Color fundus photograph, 848 by 848 pixels, modified Davis classification, NIDEK AFC-230, without pupil dilation, 45° field of view
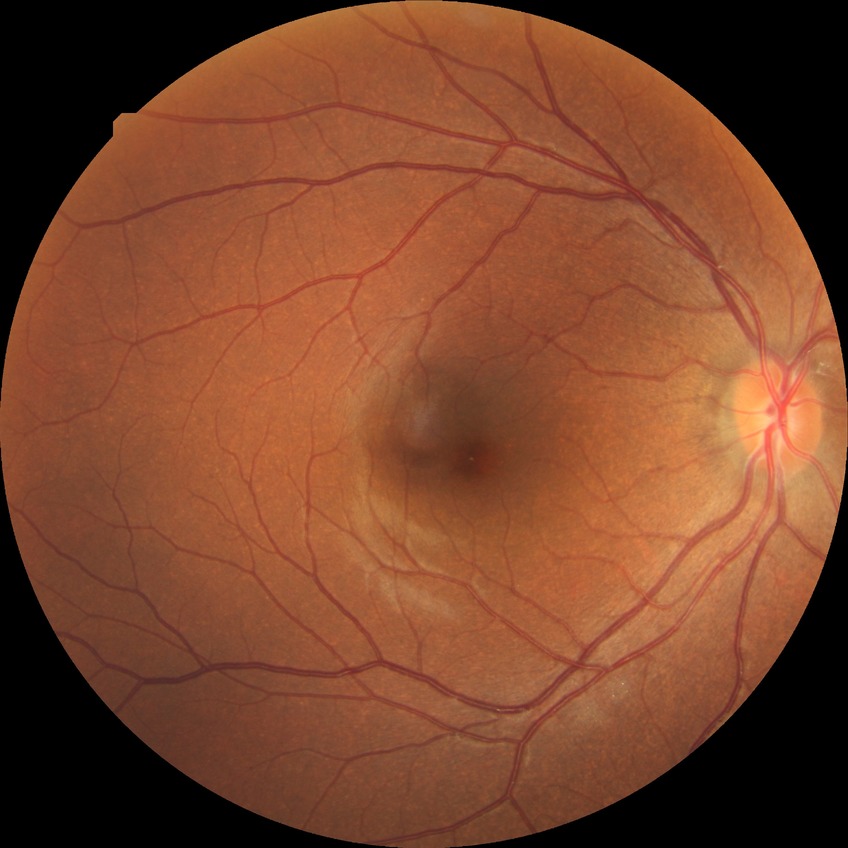

Diabetic retinopathy (DR): NDR (no diabetic retinopathy).